Disc-centered fundus crop.
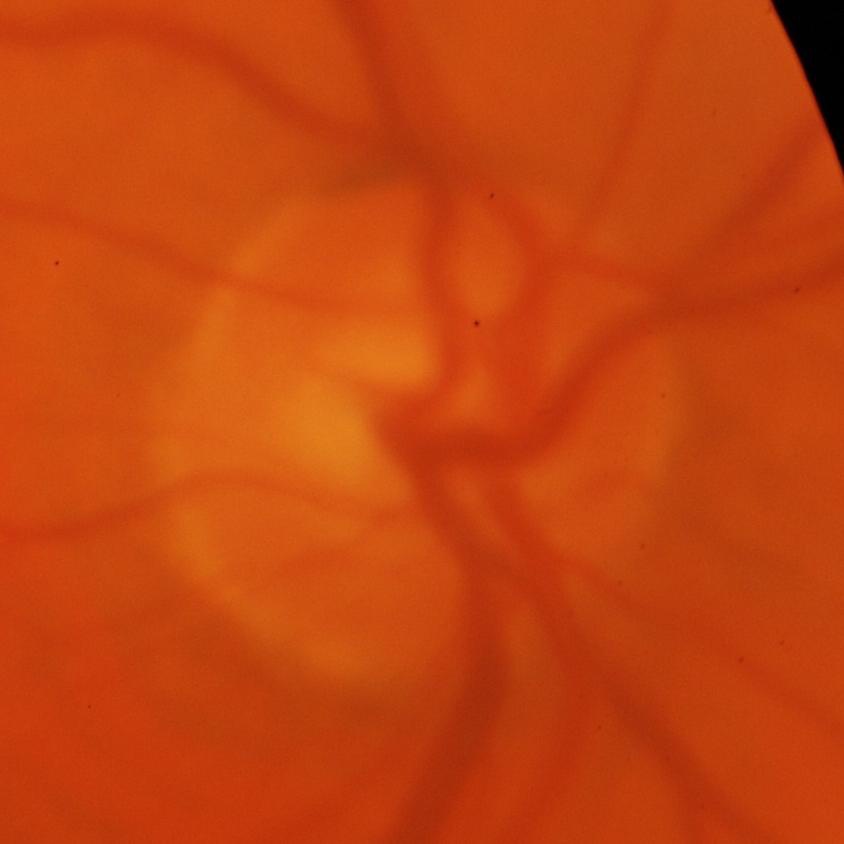

Glaucoma is present. Consistent with glaucomatous damage to the optic nerve.